Without pupil dilation — 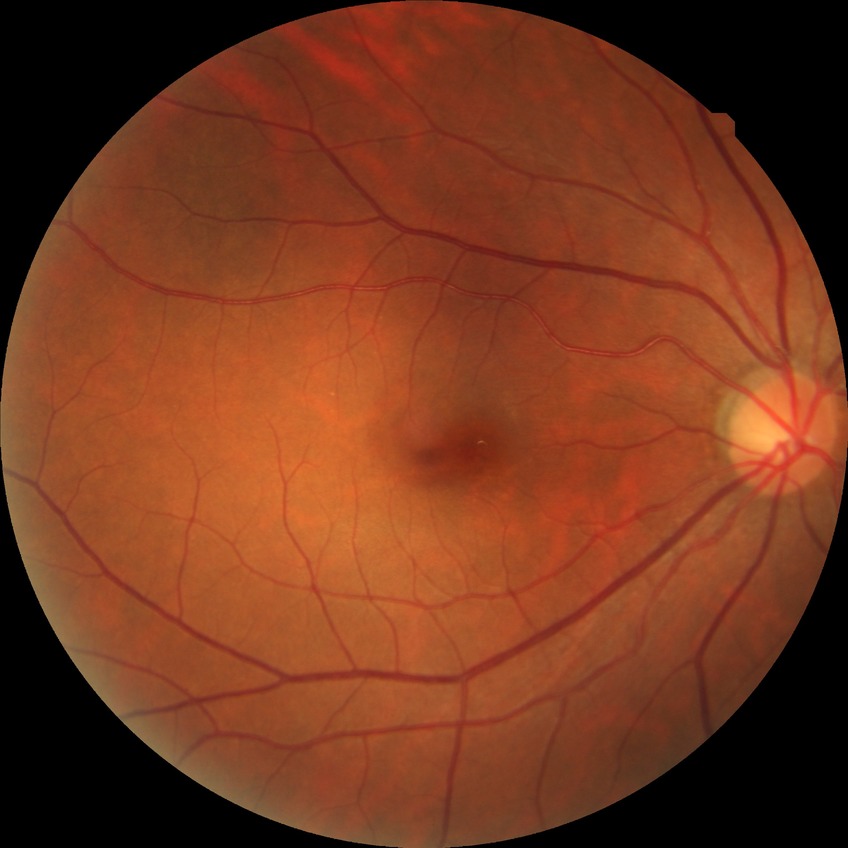

DR is NDR.